1924 x 1556 pixels, 200-degree field of view, ultra-widefield fundus photograph.
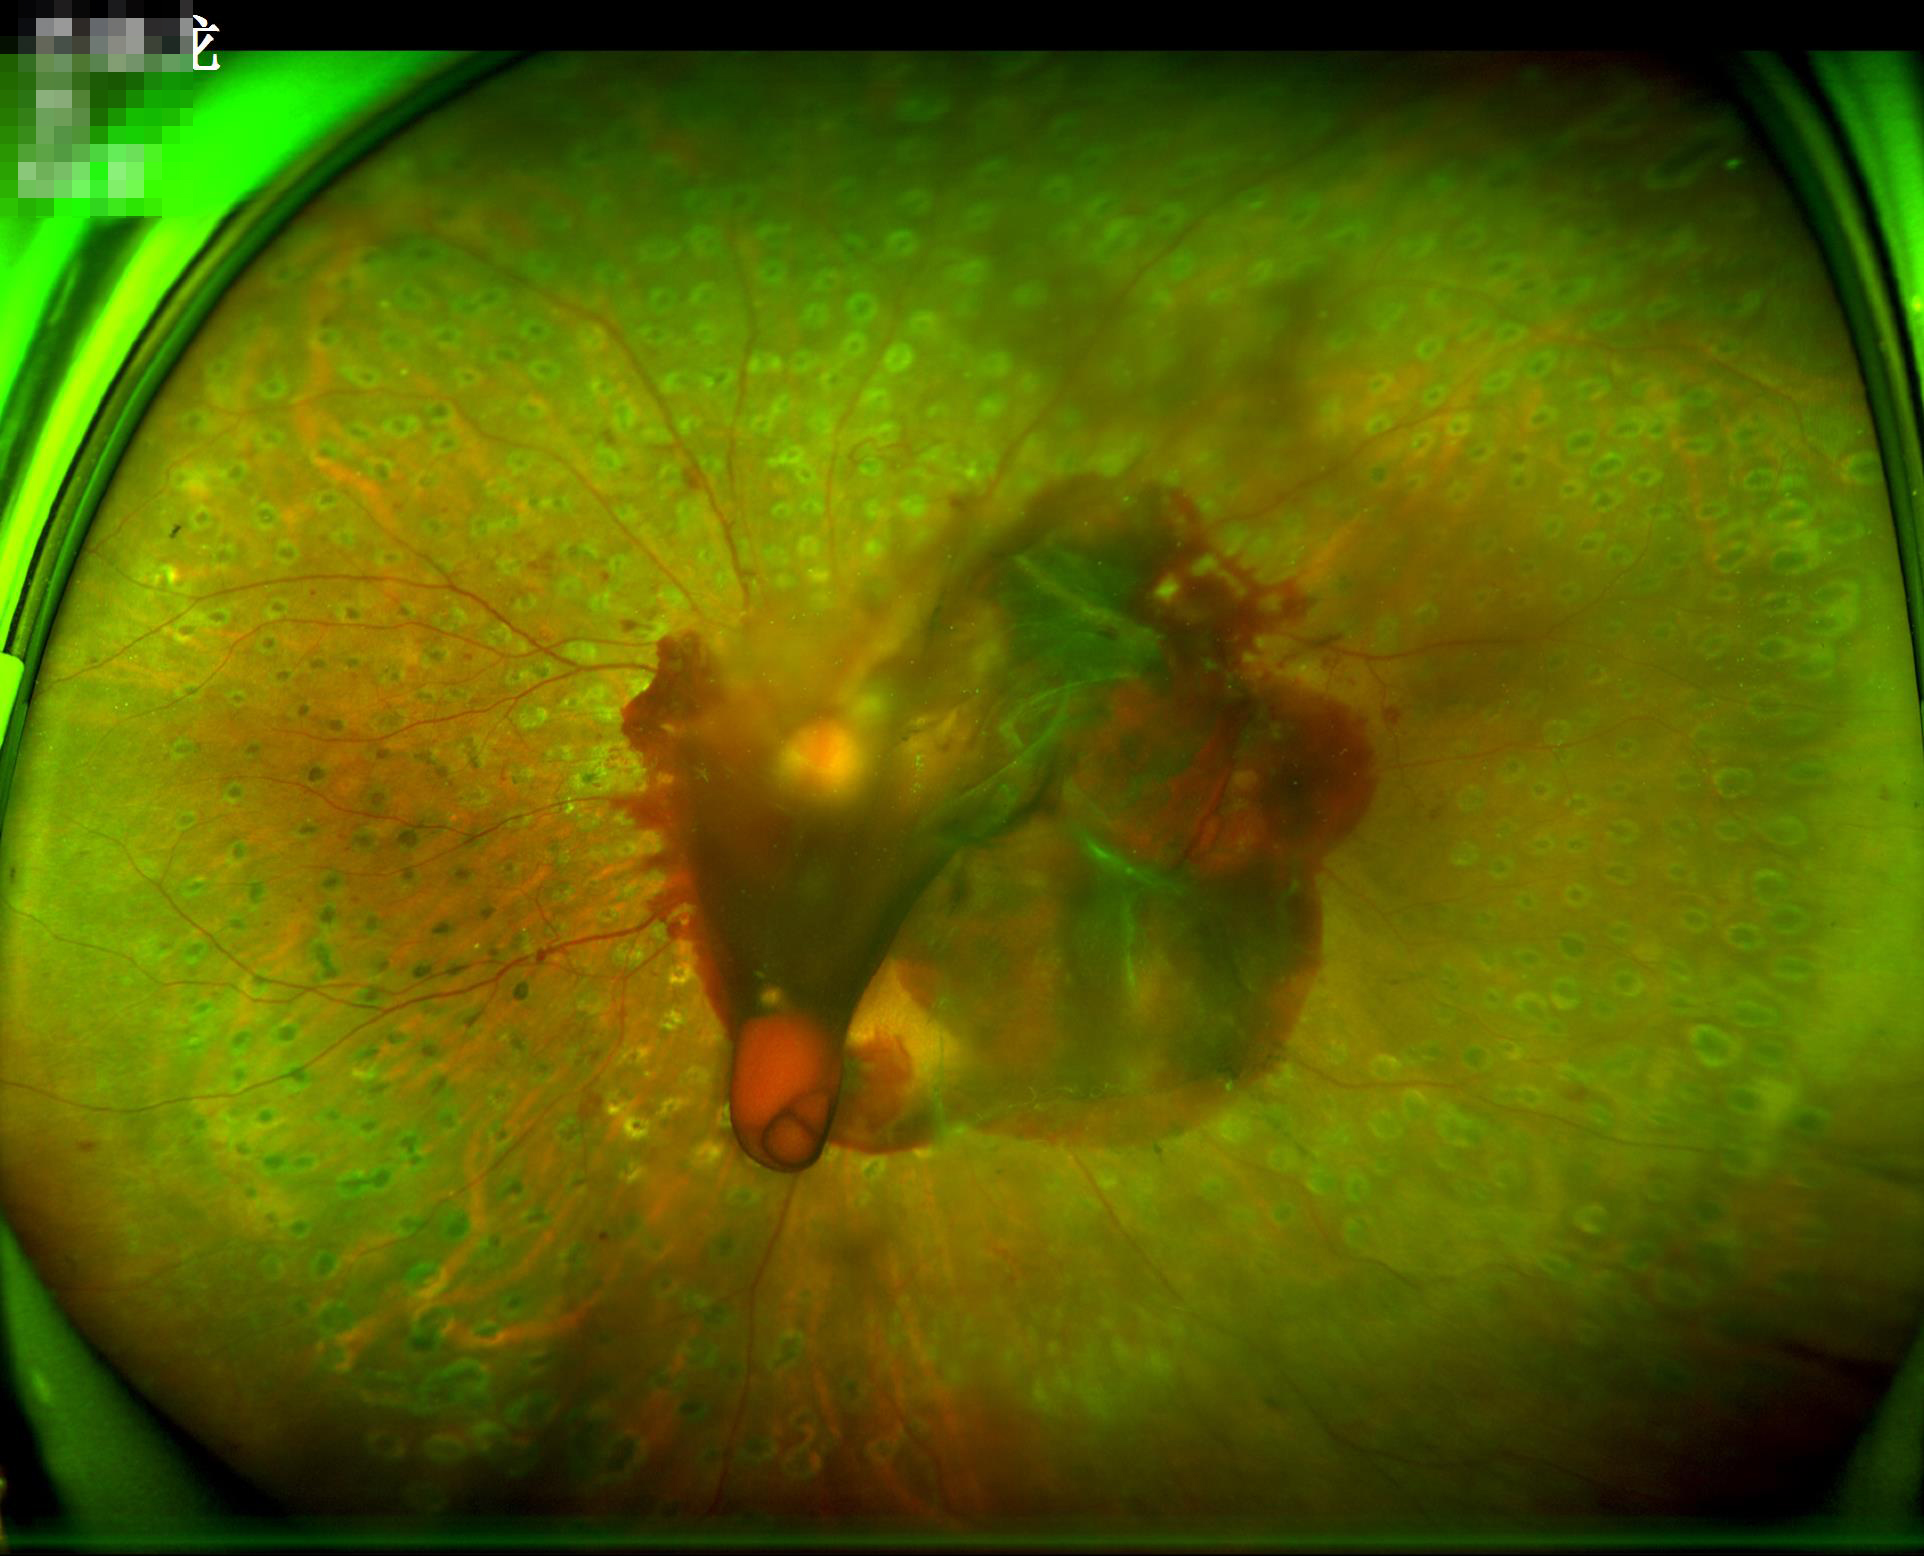 Quality assessment: illumination/color: good illumination and color balance; overall: good and suitable for diagnostic use; focus: clear with no noticeable blur.